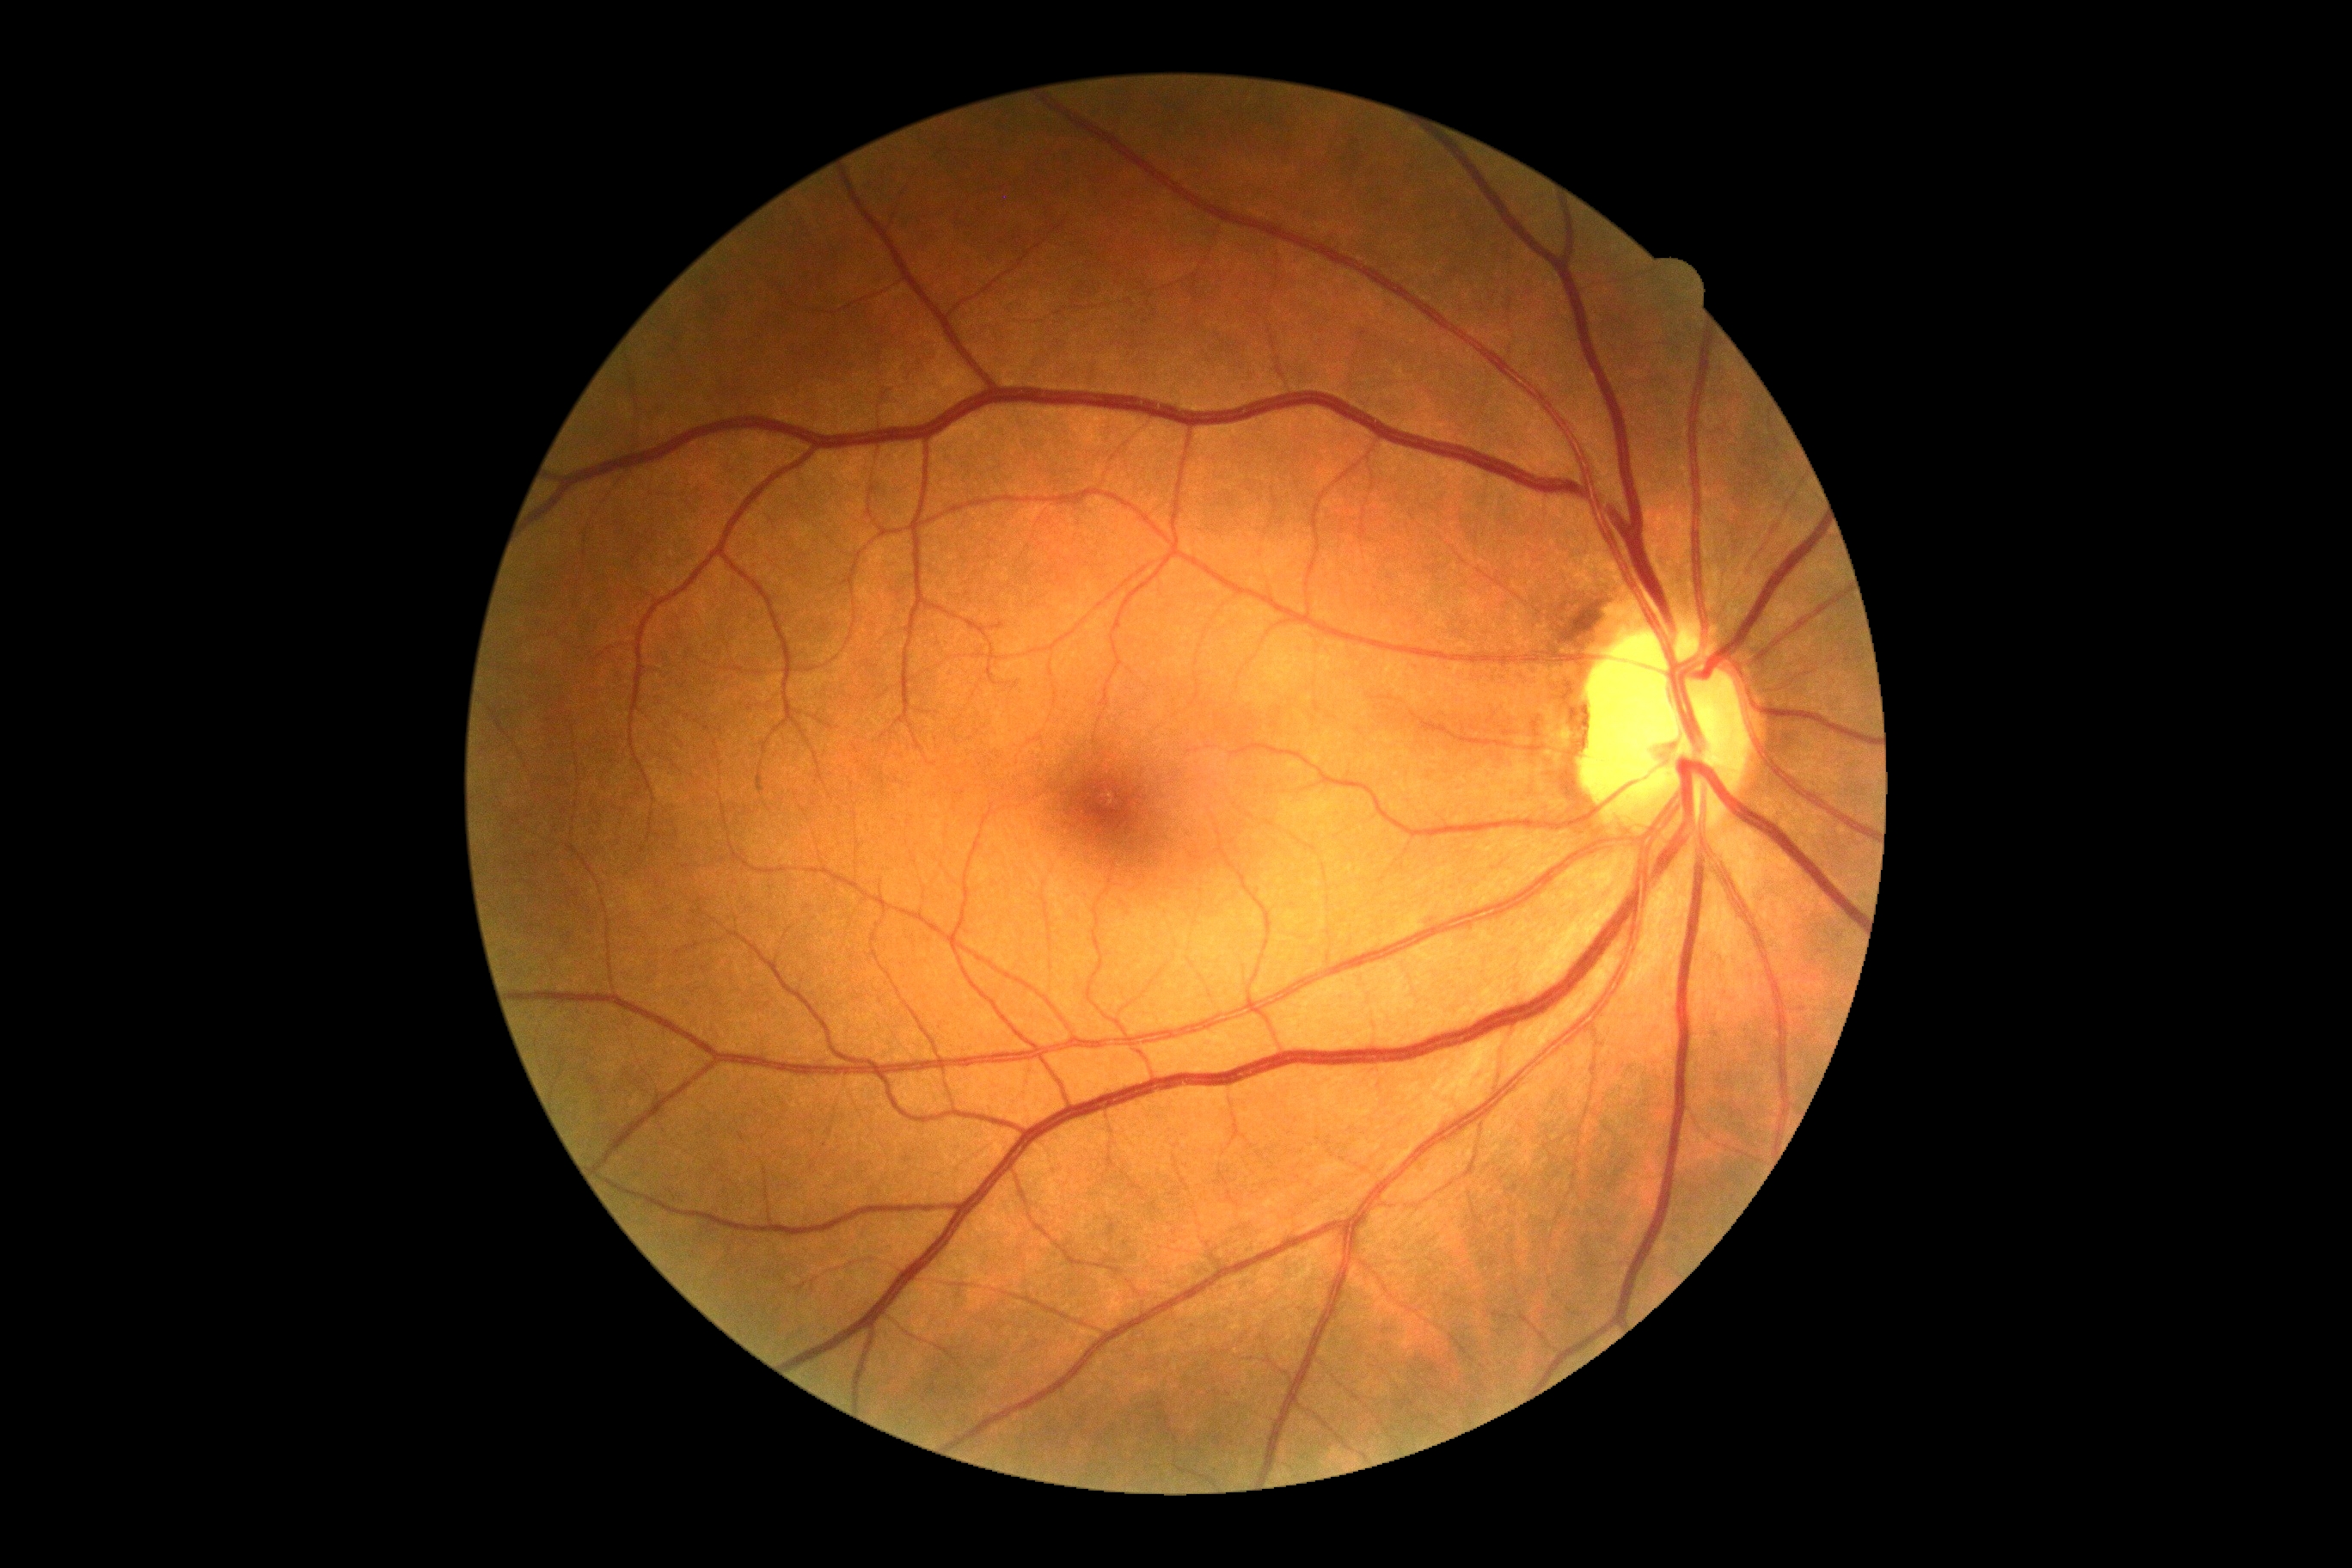 DR severity: 0.
No DR findings.